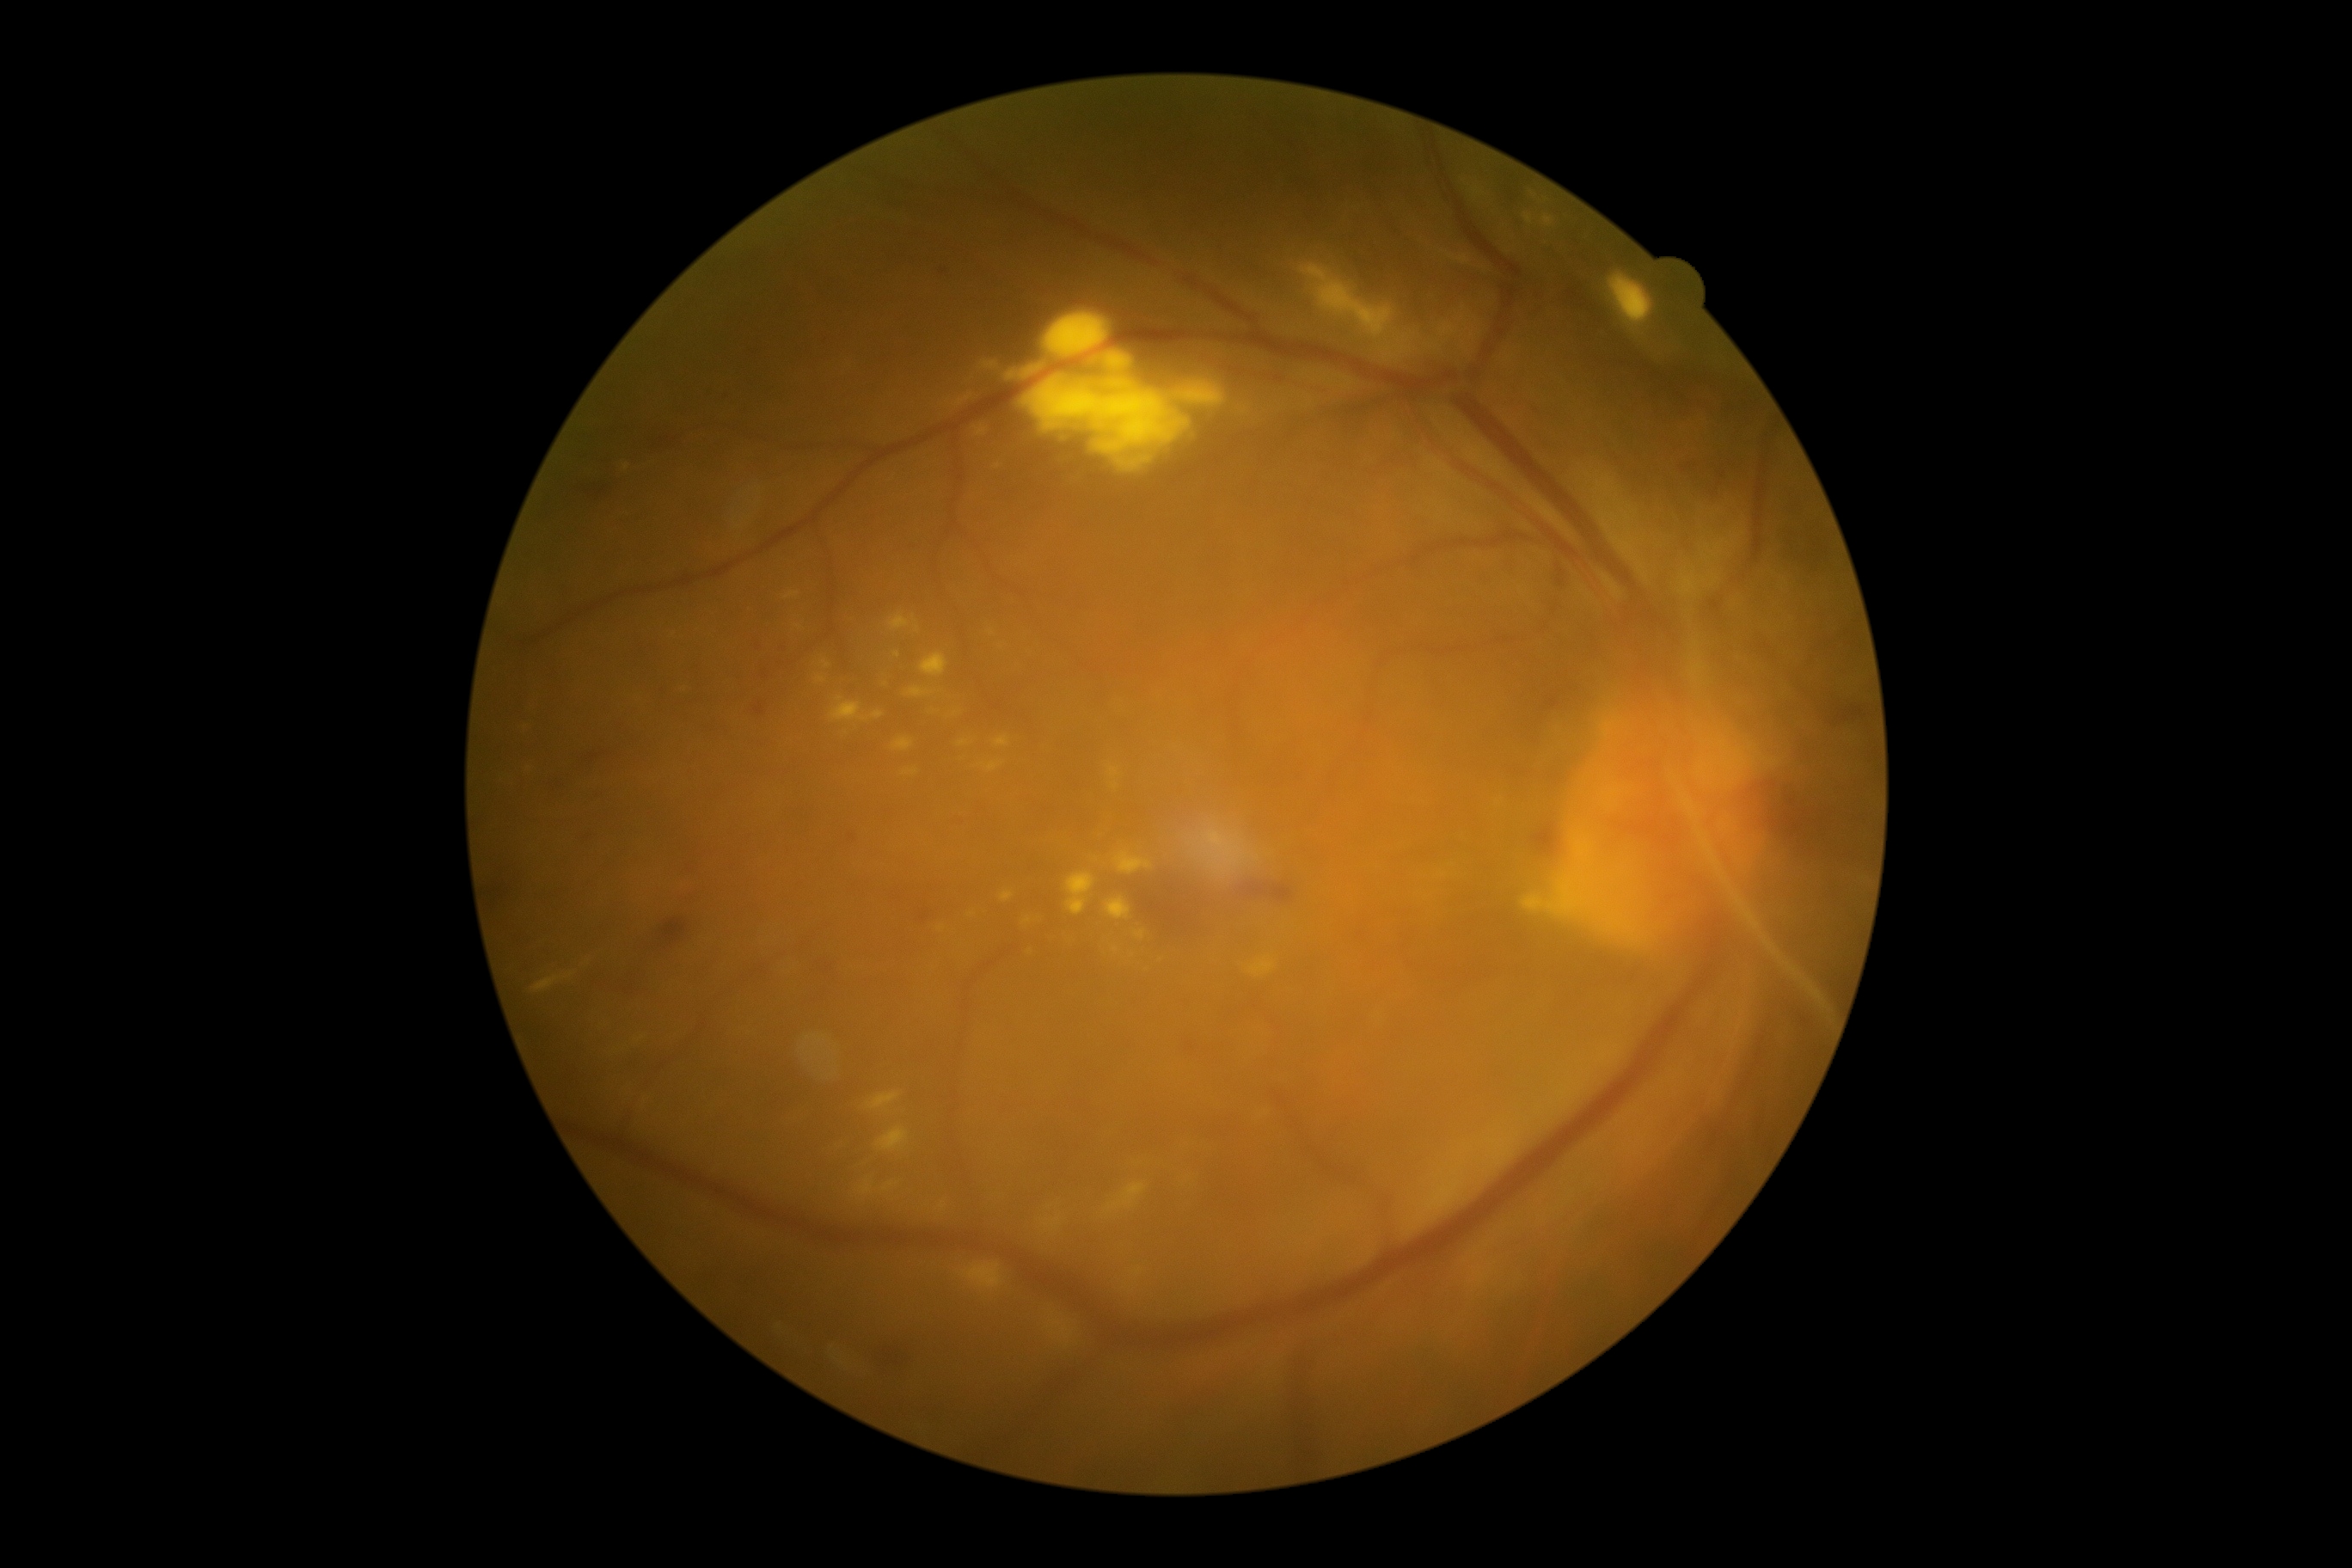 Diabetic retinopathy grade is 4 (PDR)
Lesions identified (partial list):
hard exudates (continued): box=[907, 689, 933, 697] | box=[890, 615, 910, 632] | box=[1026, 367, 1041, 376] | box=[1106, 1182, 1146, 1211] | box=[1089, 355, 1098, 365] | box=[1130, 450, 1146, 456] | box=[878, 1127, 909, 1153] | box=[1438, 324, 1461, 338] | box=[1211, 830, 1225, 836] | box=[1608, 273, 1655, 329] | box=[1103, 353, 1132, 374] | box=[883, 1182, 898, 1192] | box=[959, 740, 969, 747]
Additional small hard exudates near 1146/460 | 914/619 | 973/915 | 897/655 | 626/466